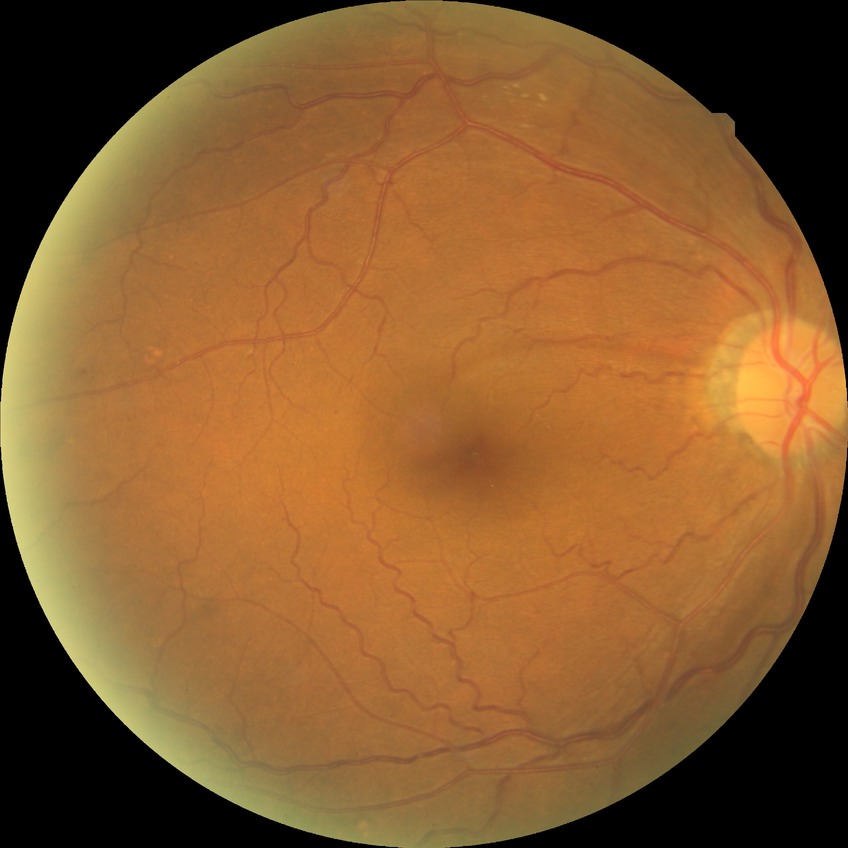 DR grade: SDR